Infant wide-field fundus photograph
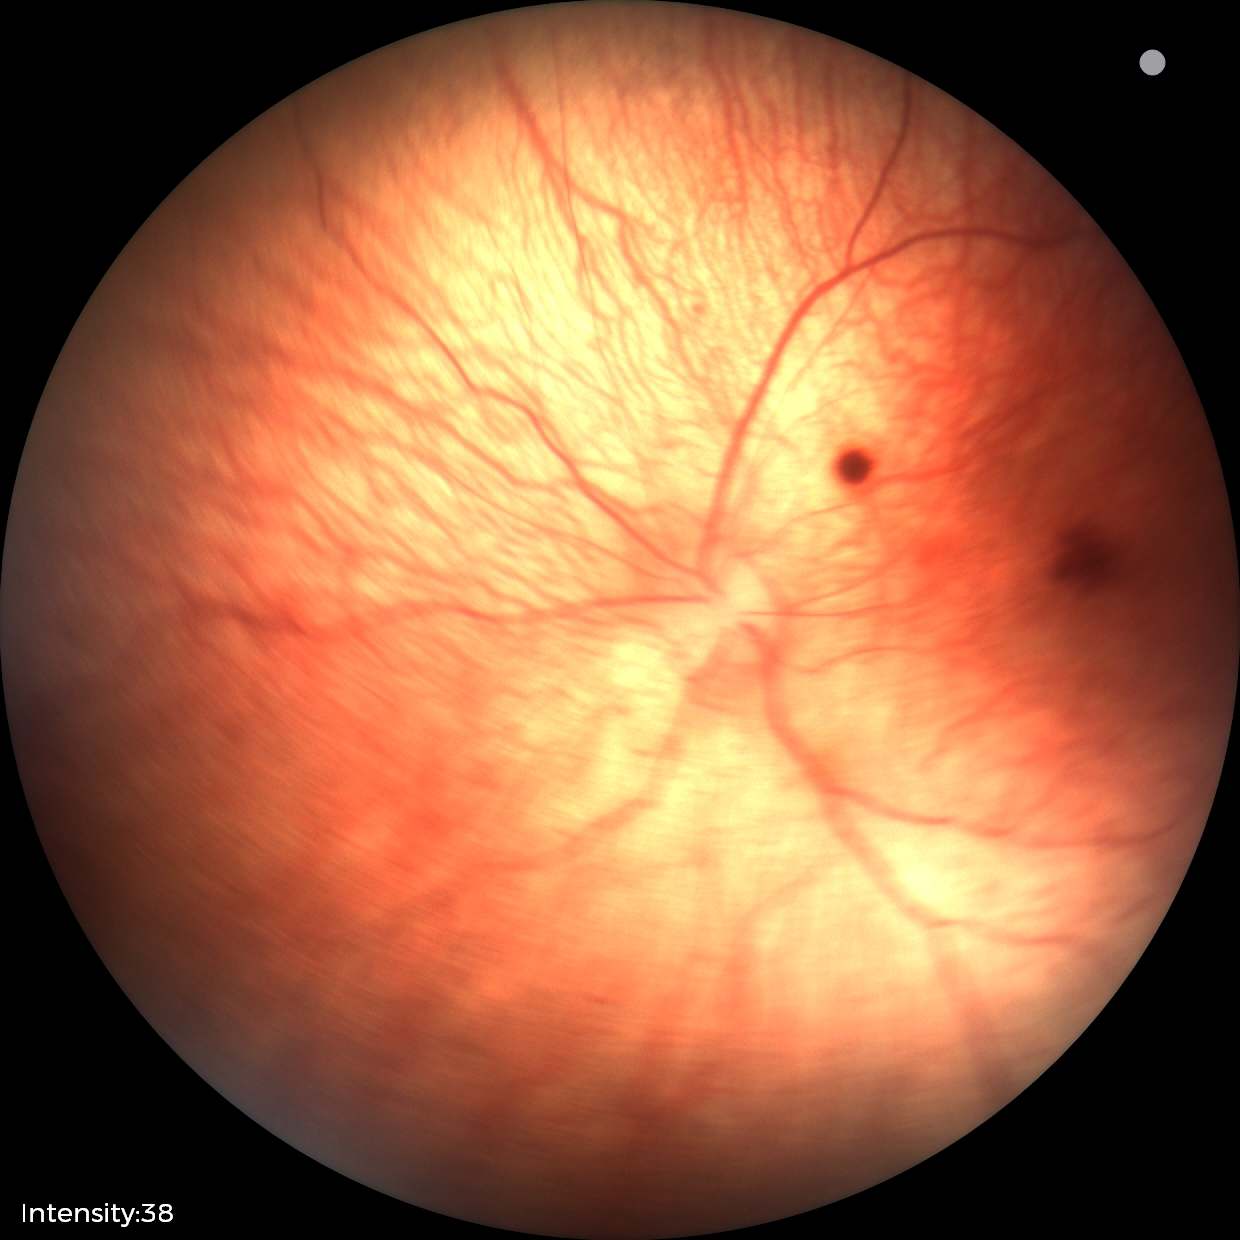

Screening diagnosis = retinal hemorrhages.